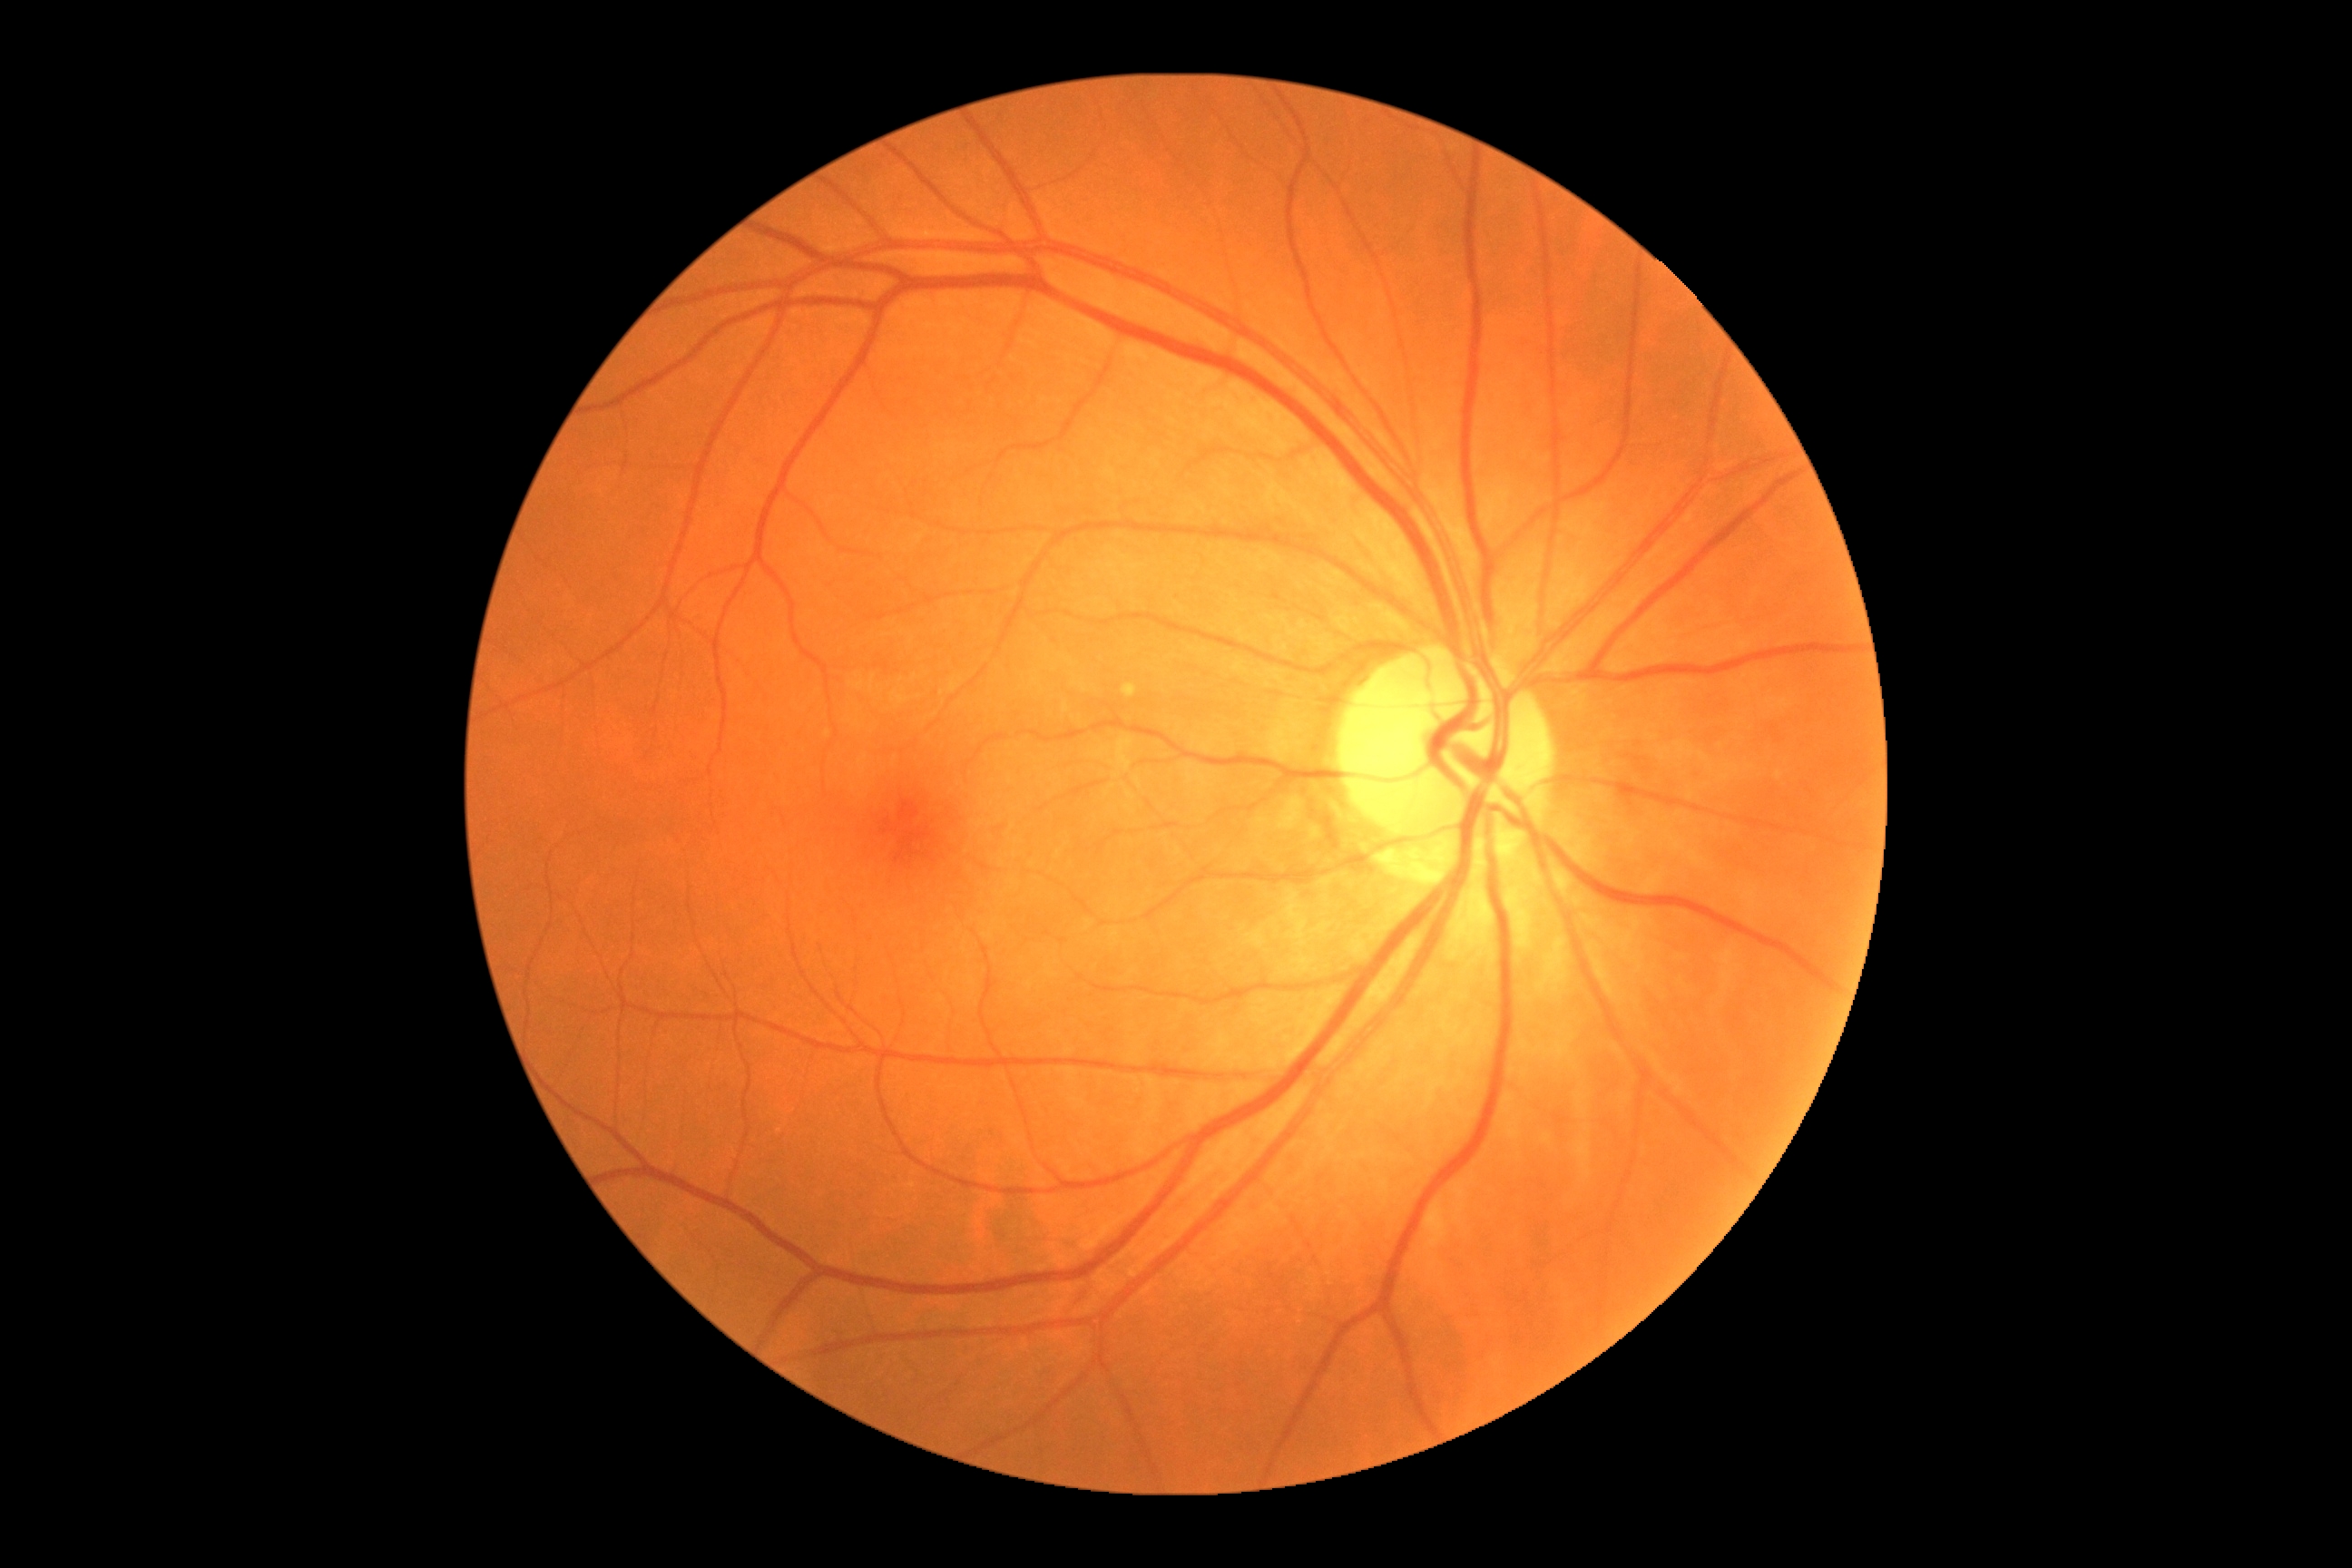 Retinopathy grade: no apparent retinopathy (0) — no visible signs of diabetic retinopathy.
No diabetic retinal disease findings.